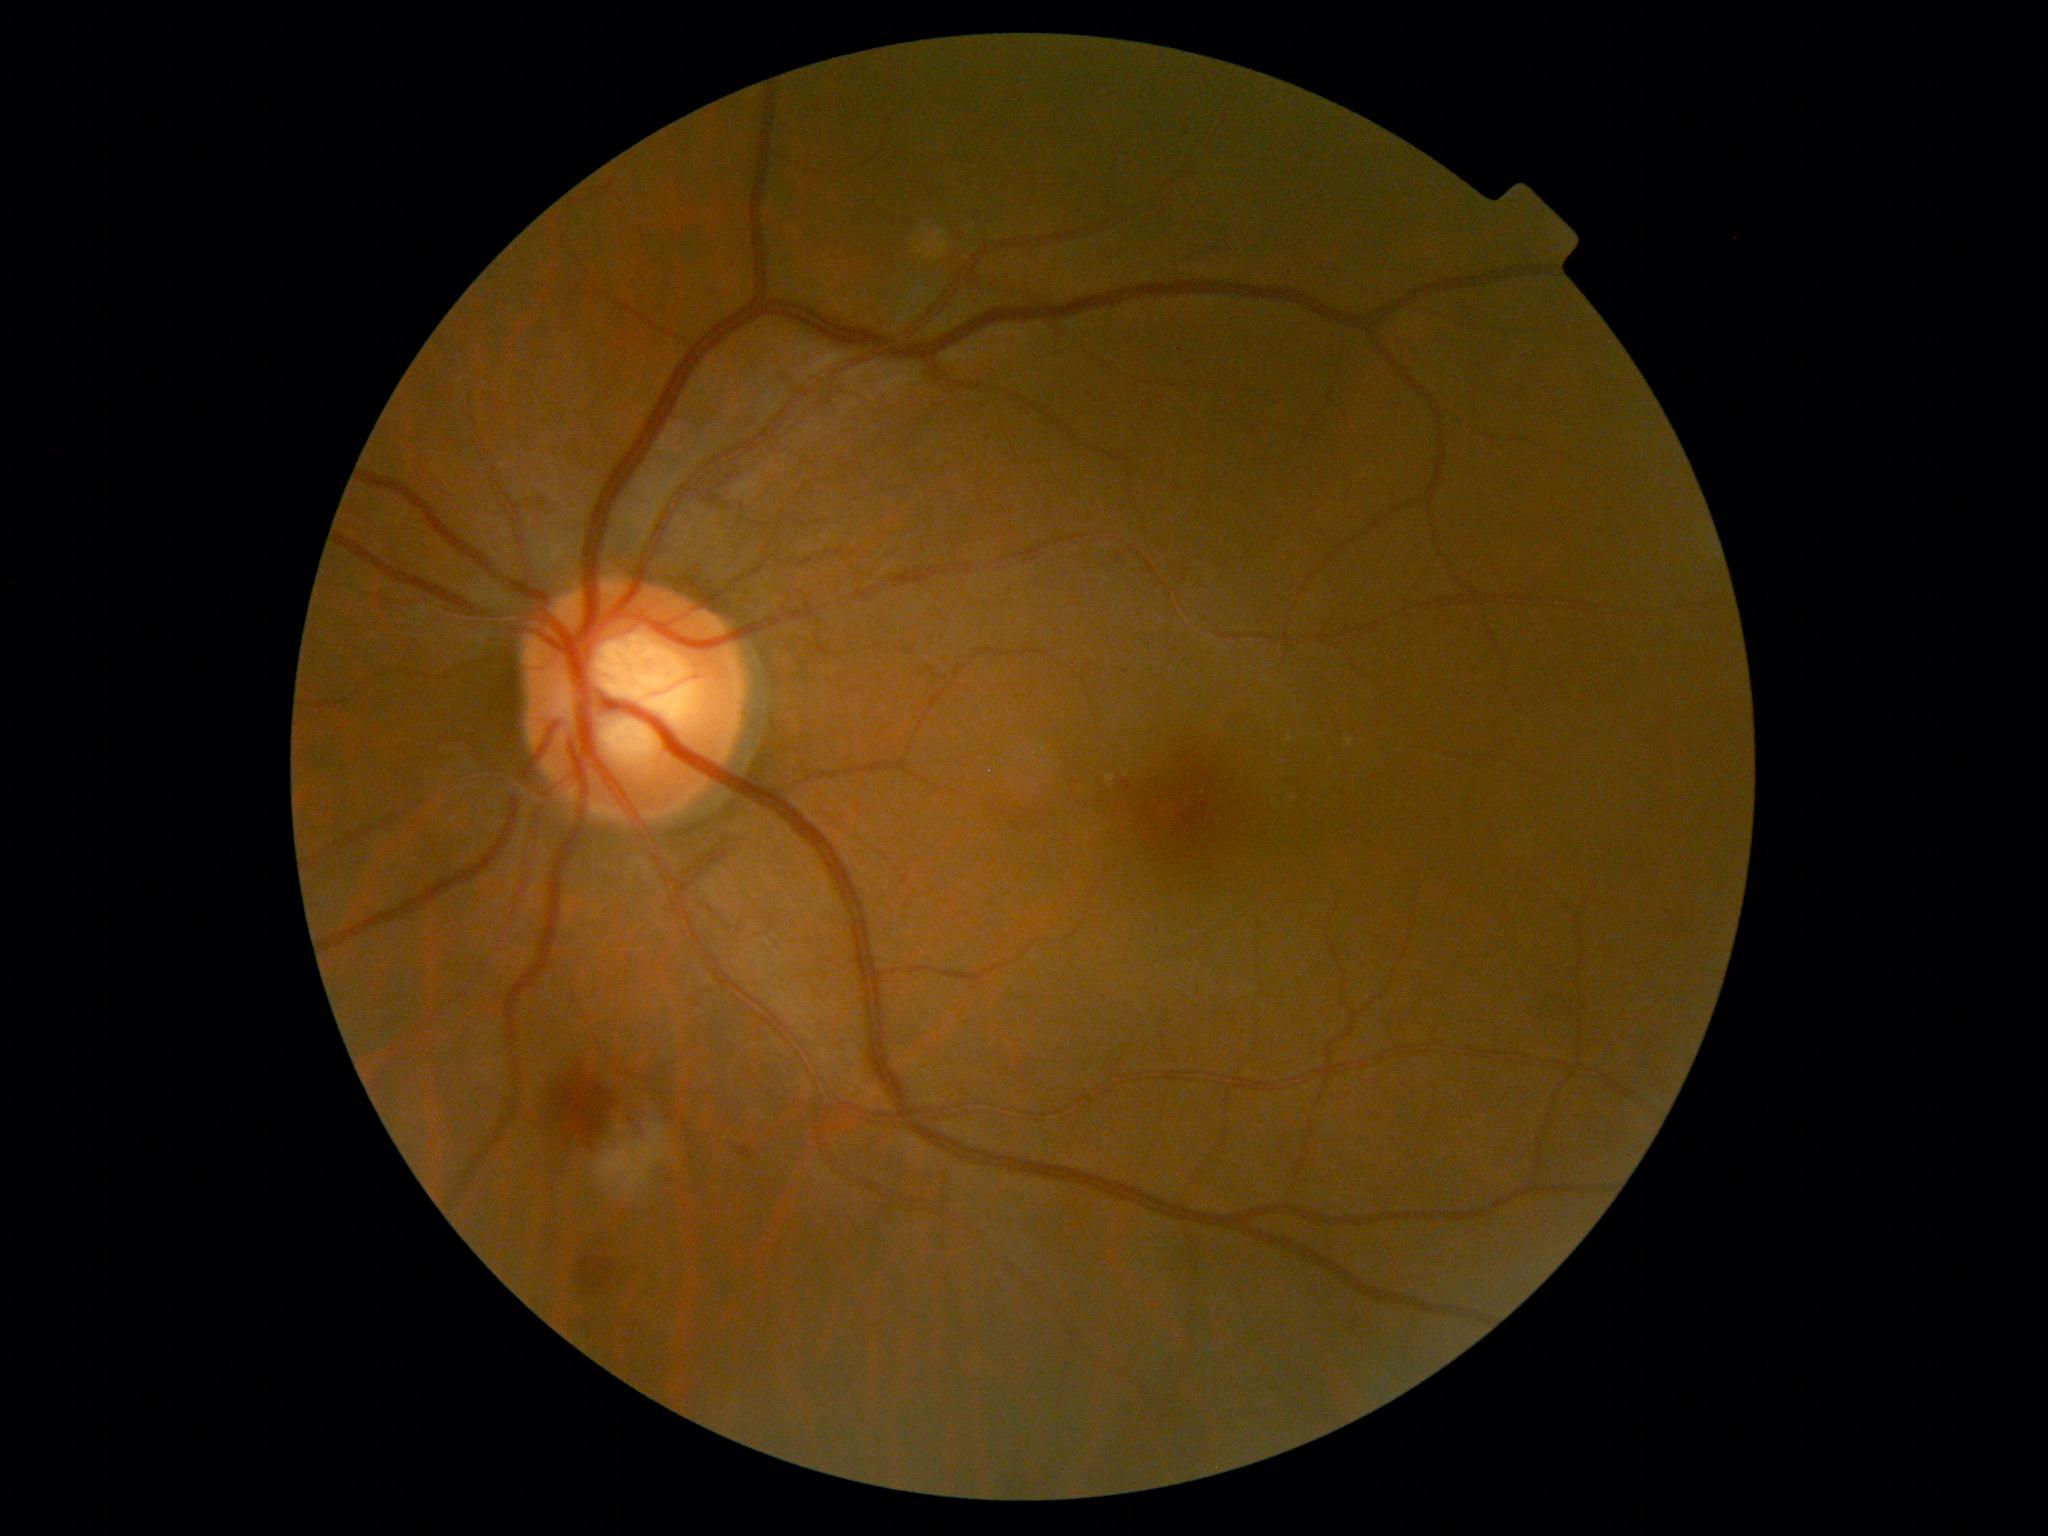 Findings:
* DR grade: moderate NPDR (2)